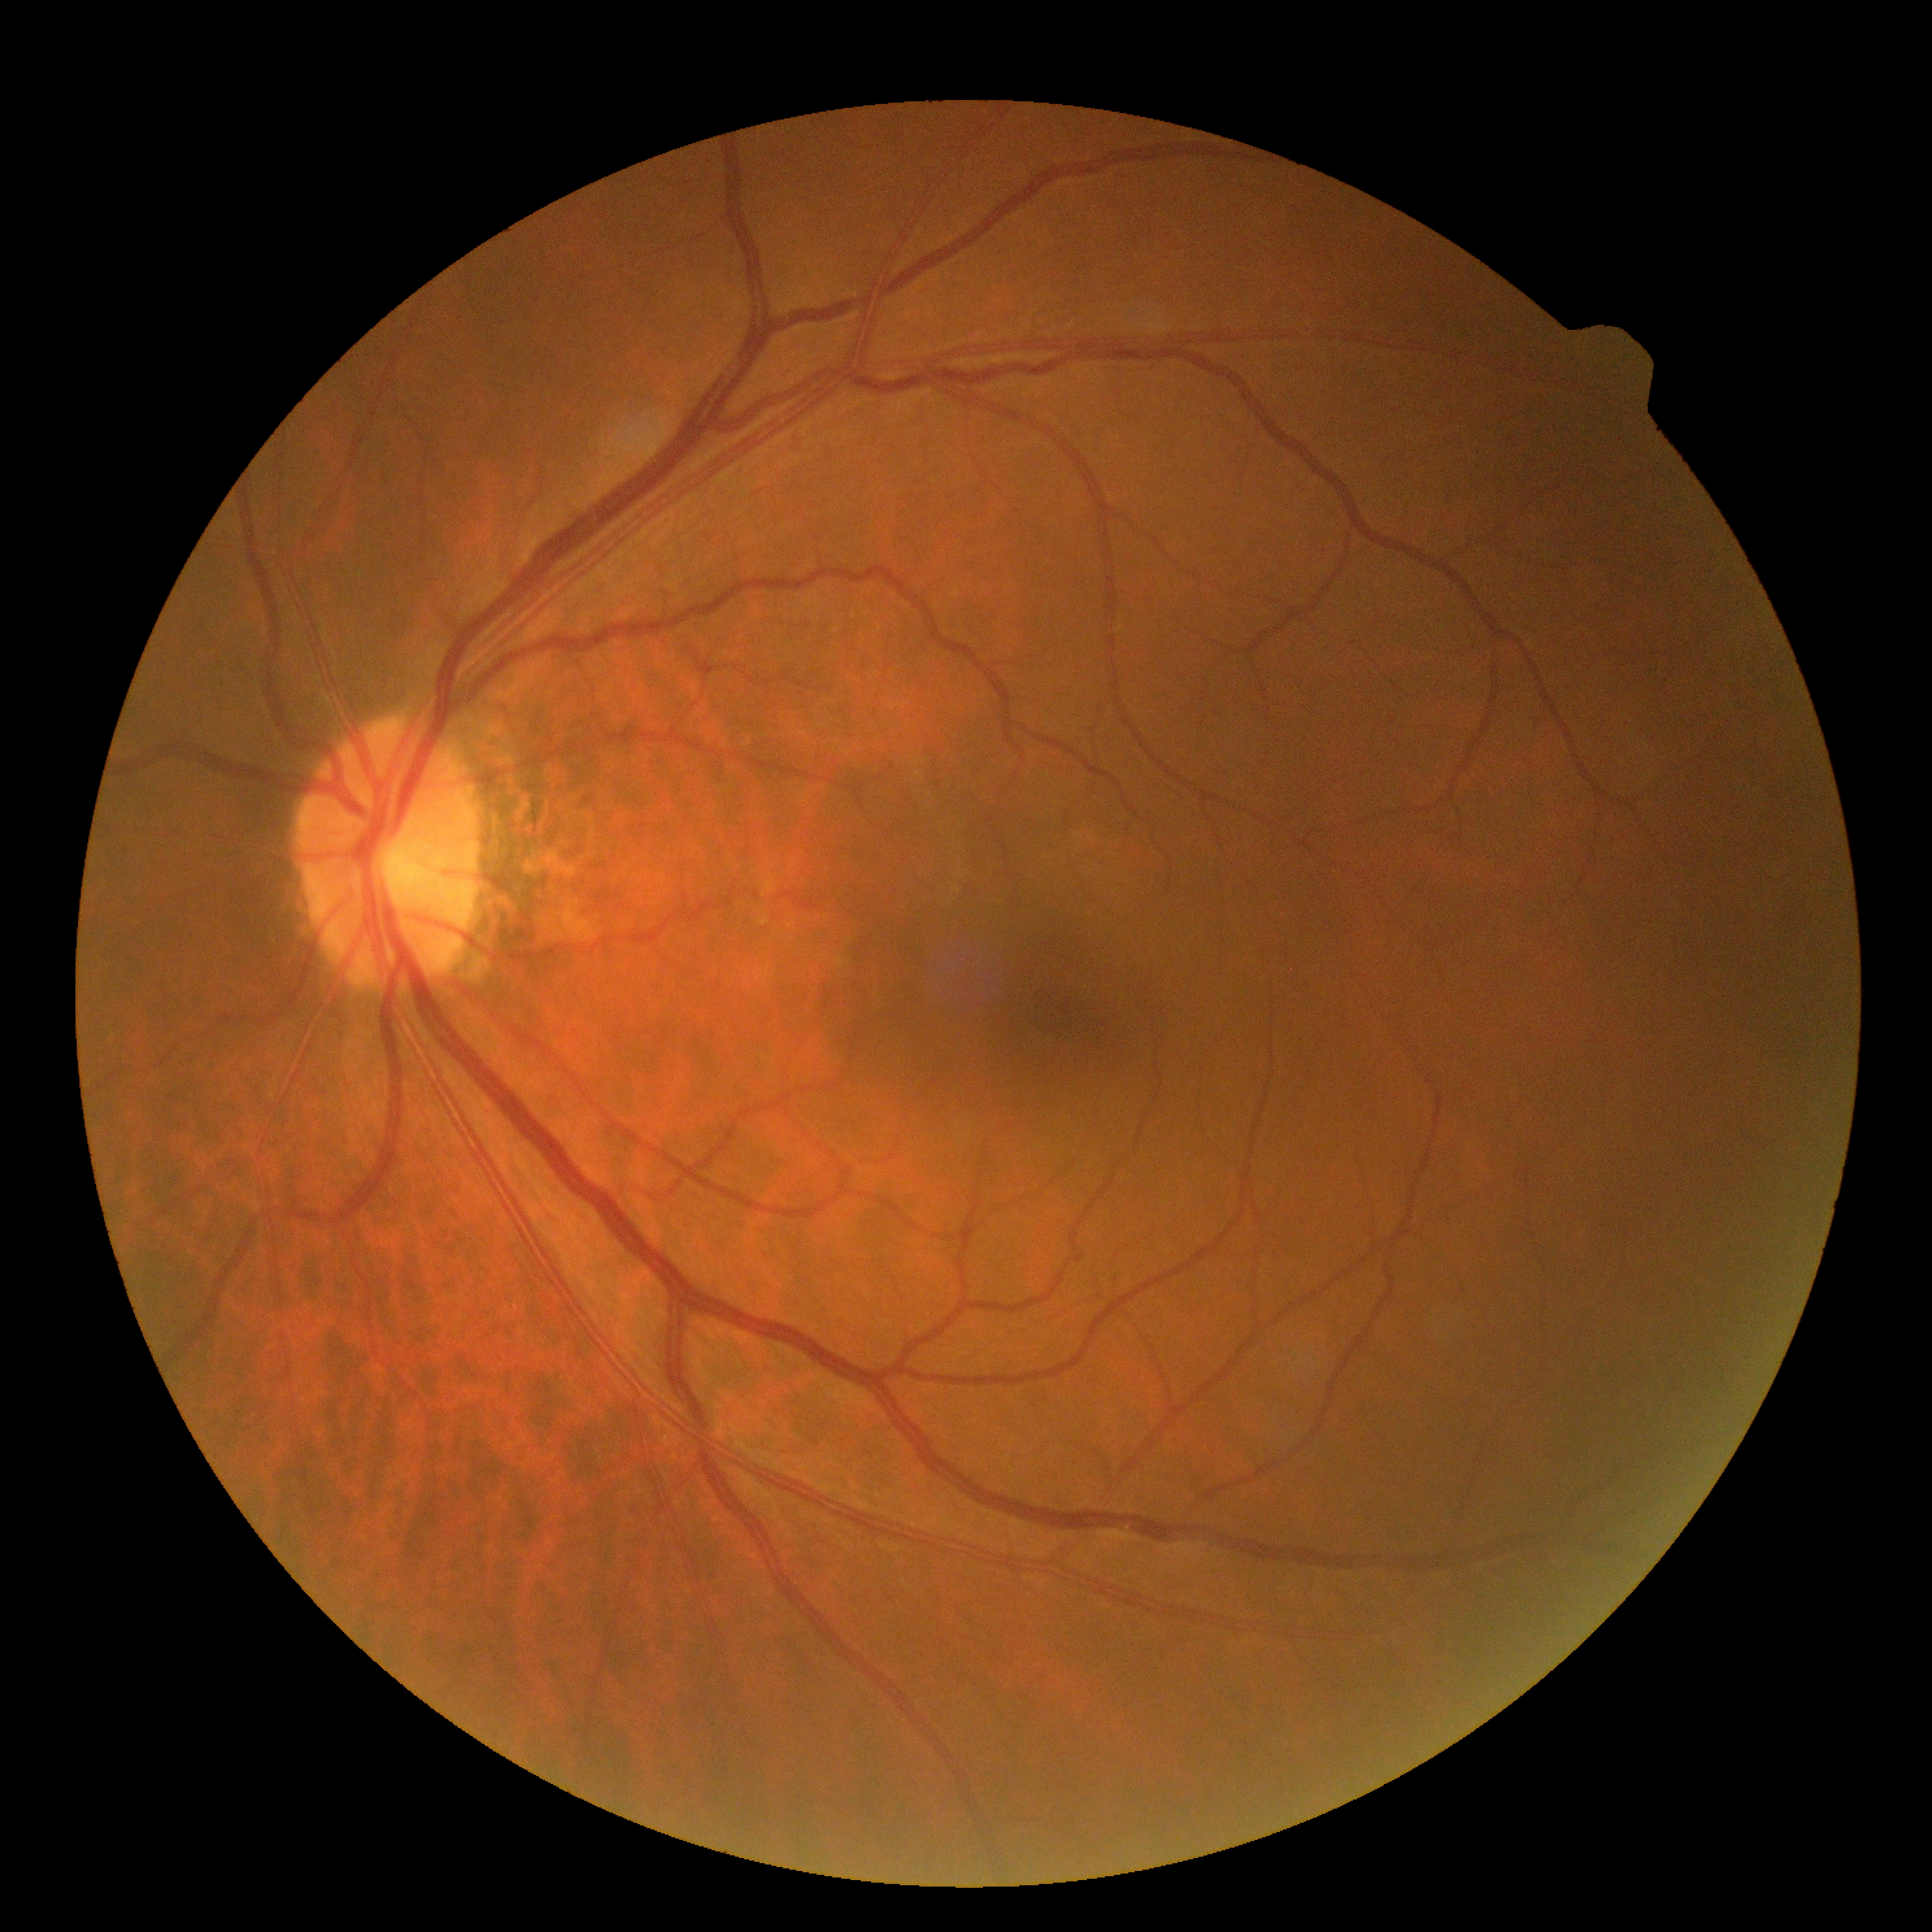 diabetic retinopathy@no apparent diabetic retinopathy (grade 0).